45-degree field of view, 848 x 848 pixels, retinal fundus photograph, Davis DR grading.
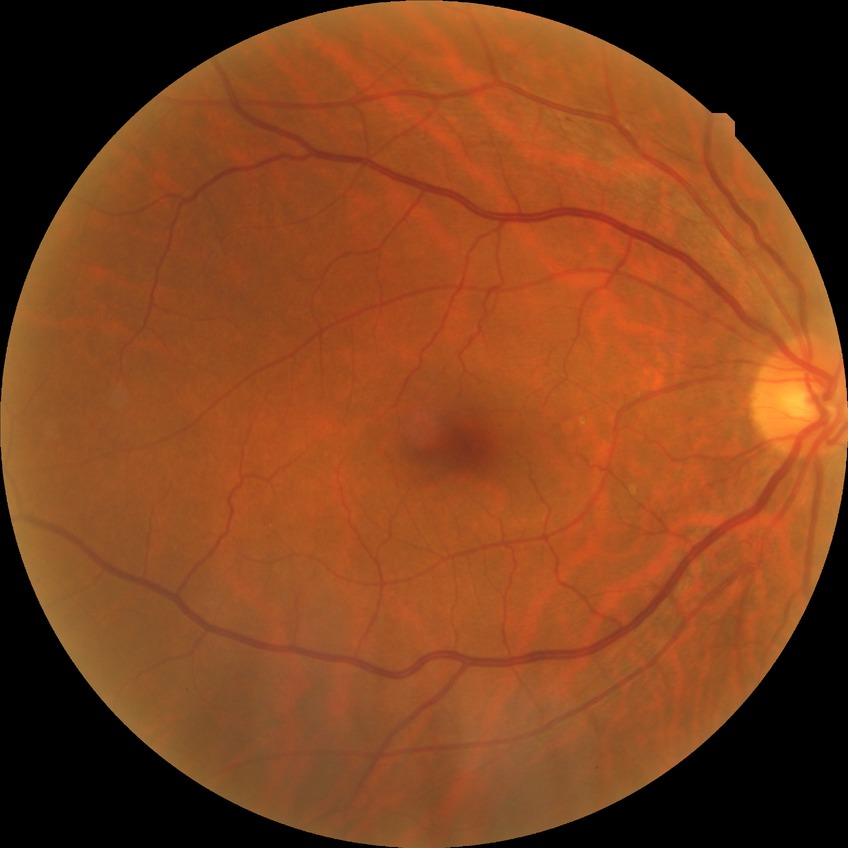 No DR findings.
DR grade: NDR.